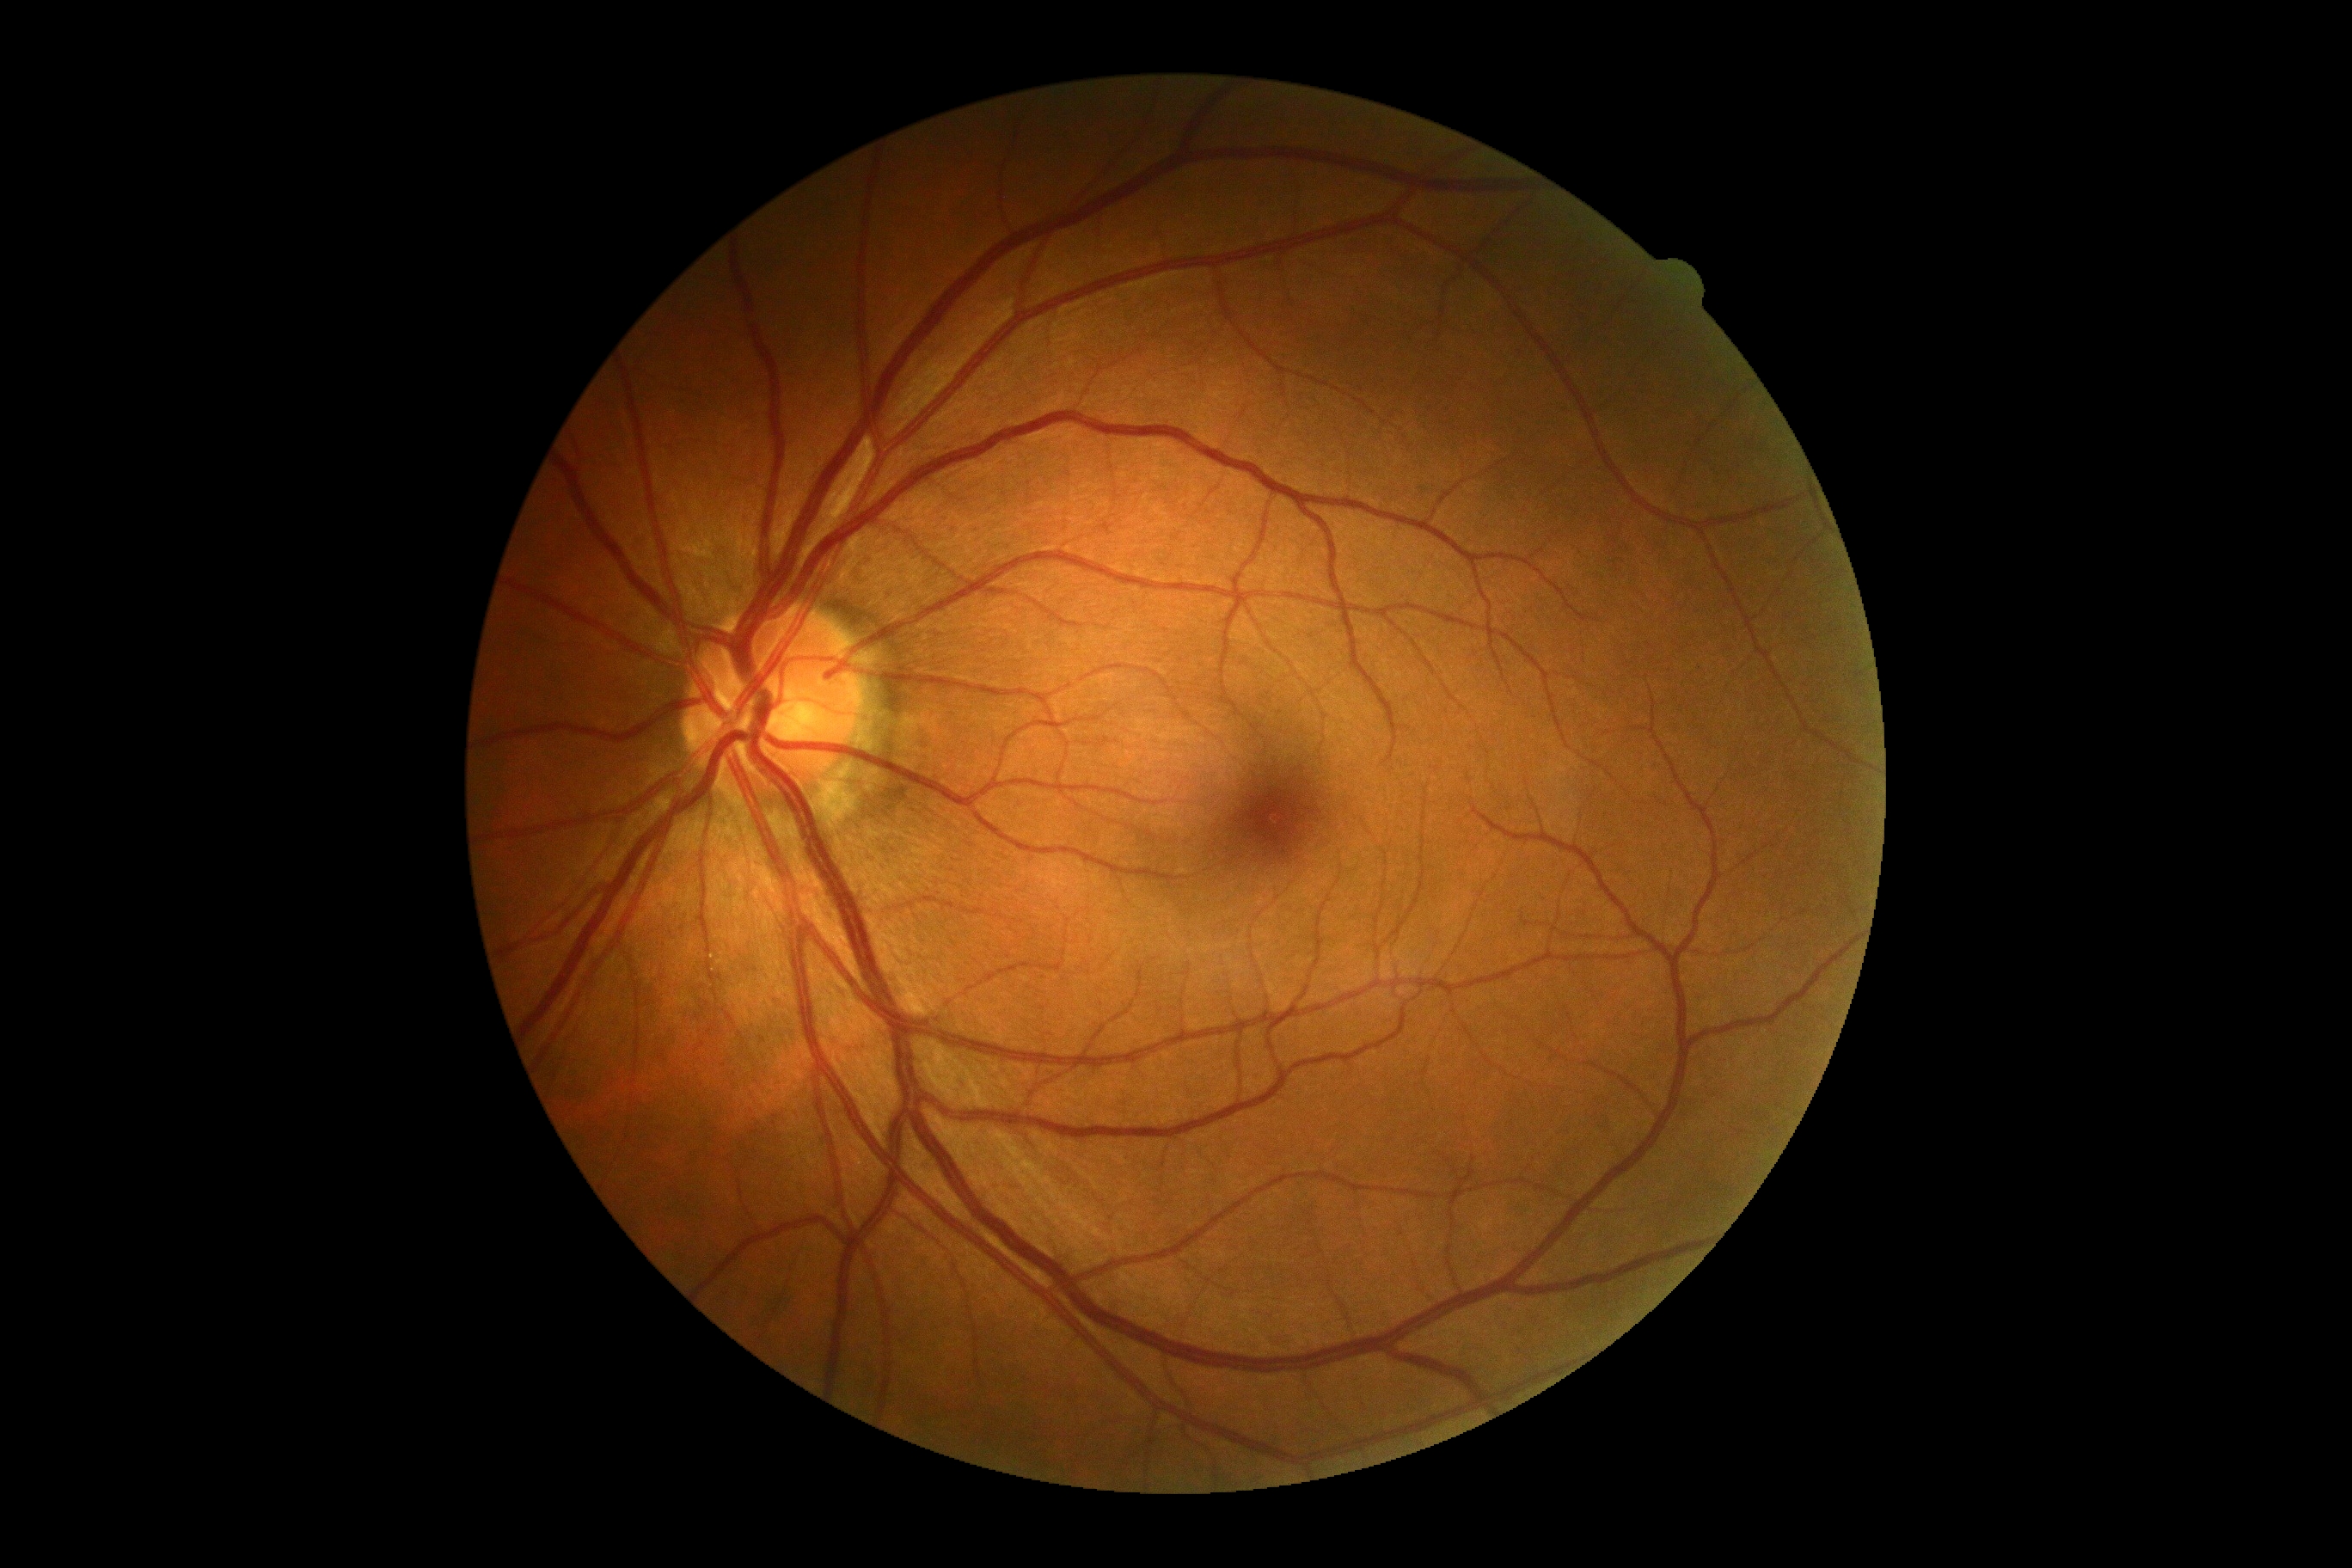
No diabetic retinal disease findings. Diabetic retinopathy (DR): no apparent diabetic retinopathy (grade 0).